CFP:
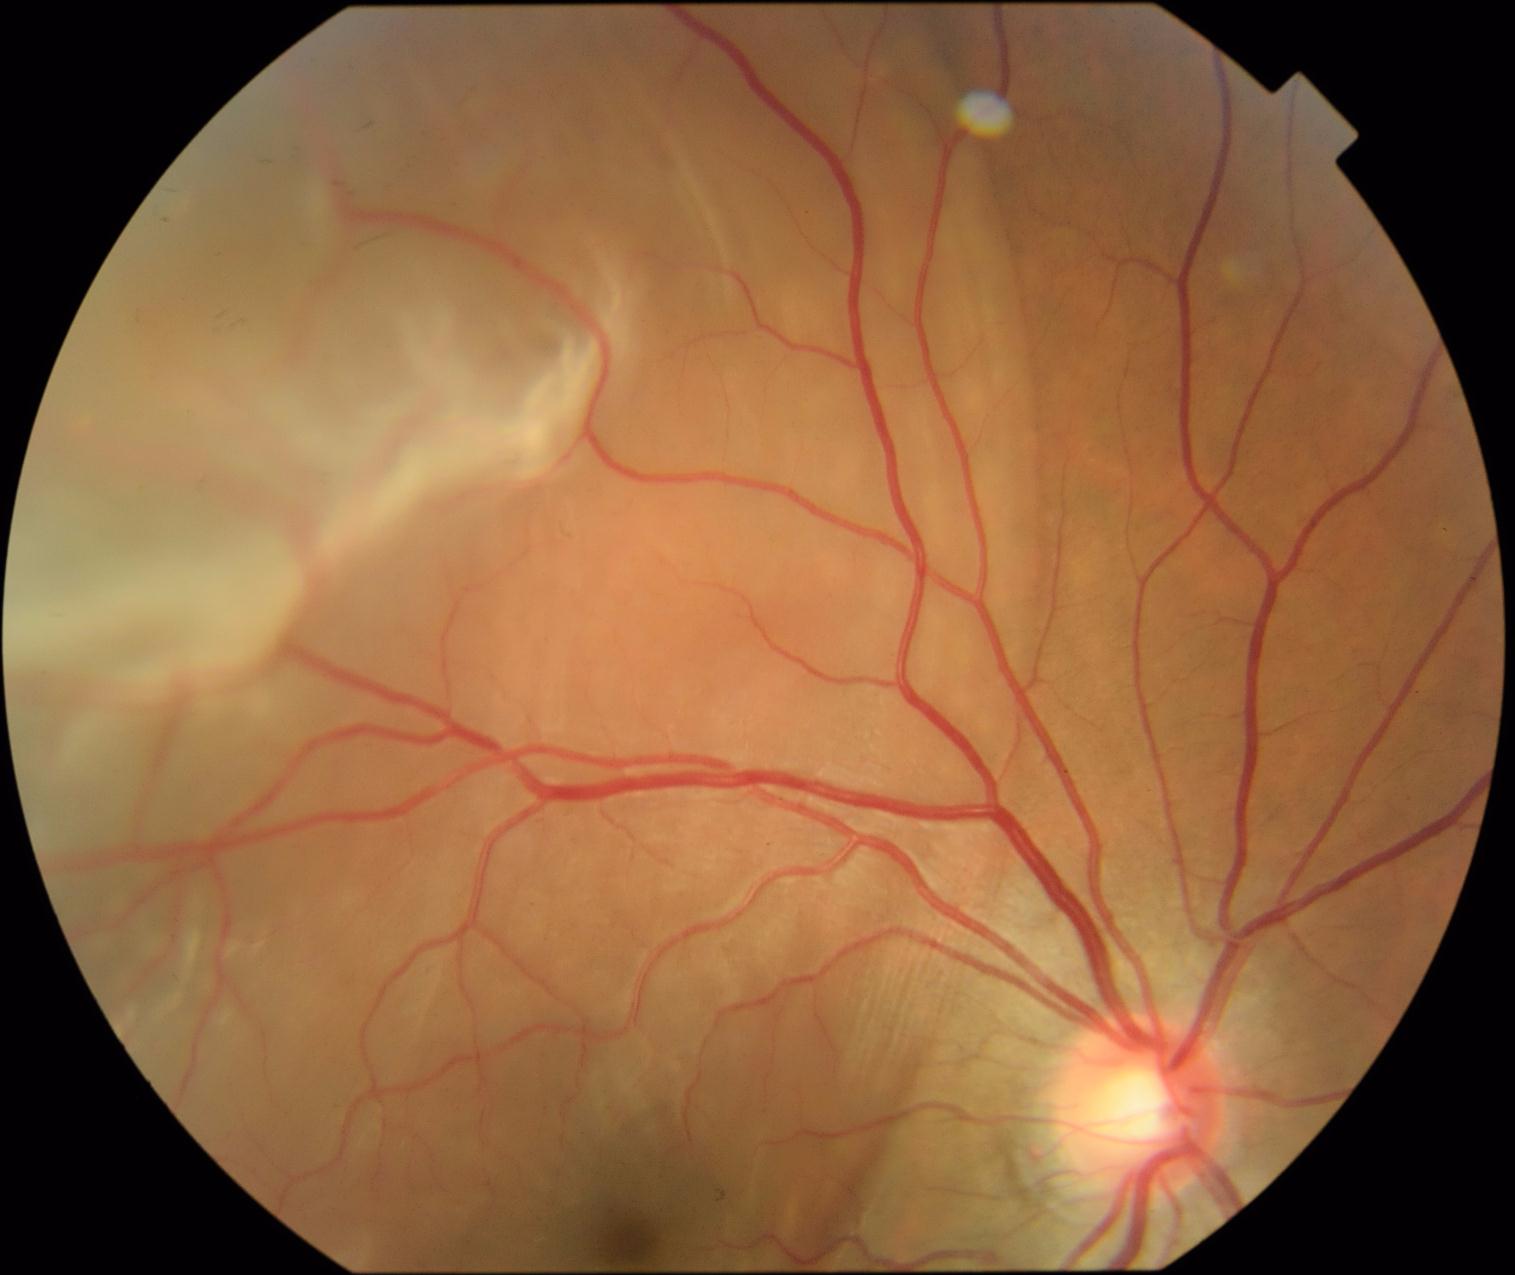

Diabetic retinopathy severity is 4/4.